848 x 848 pixels: 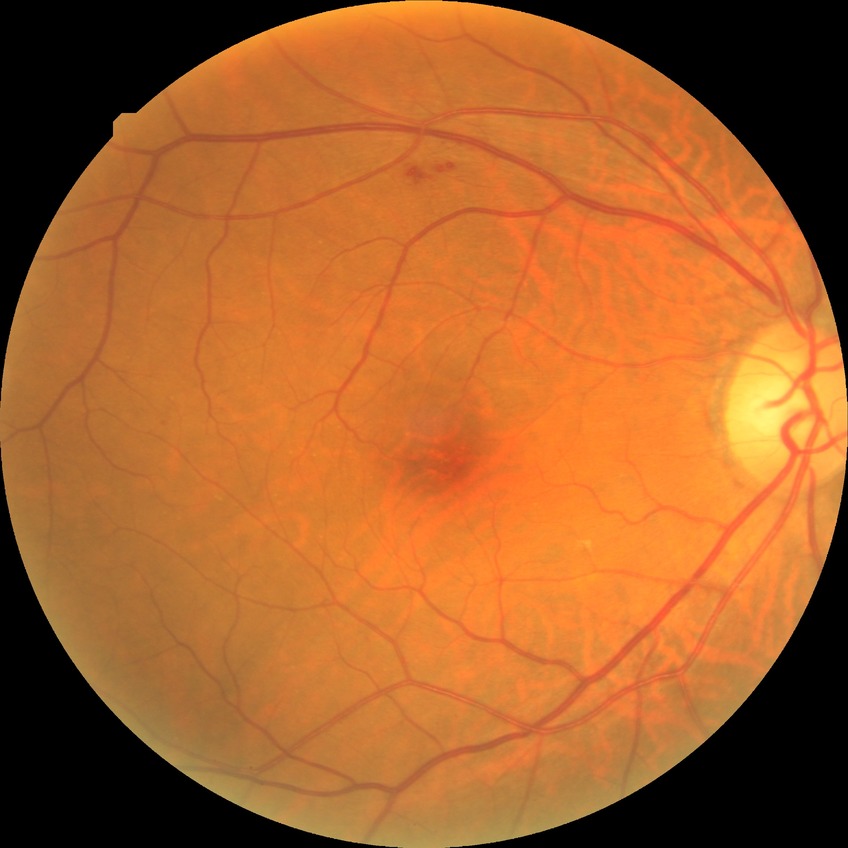

Diabetic retinopathy (DR): simple diabetic retinopathy (SDR).